45° FOV:
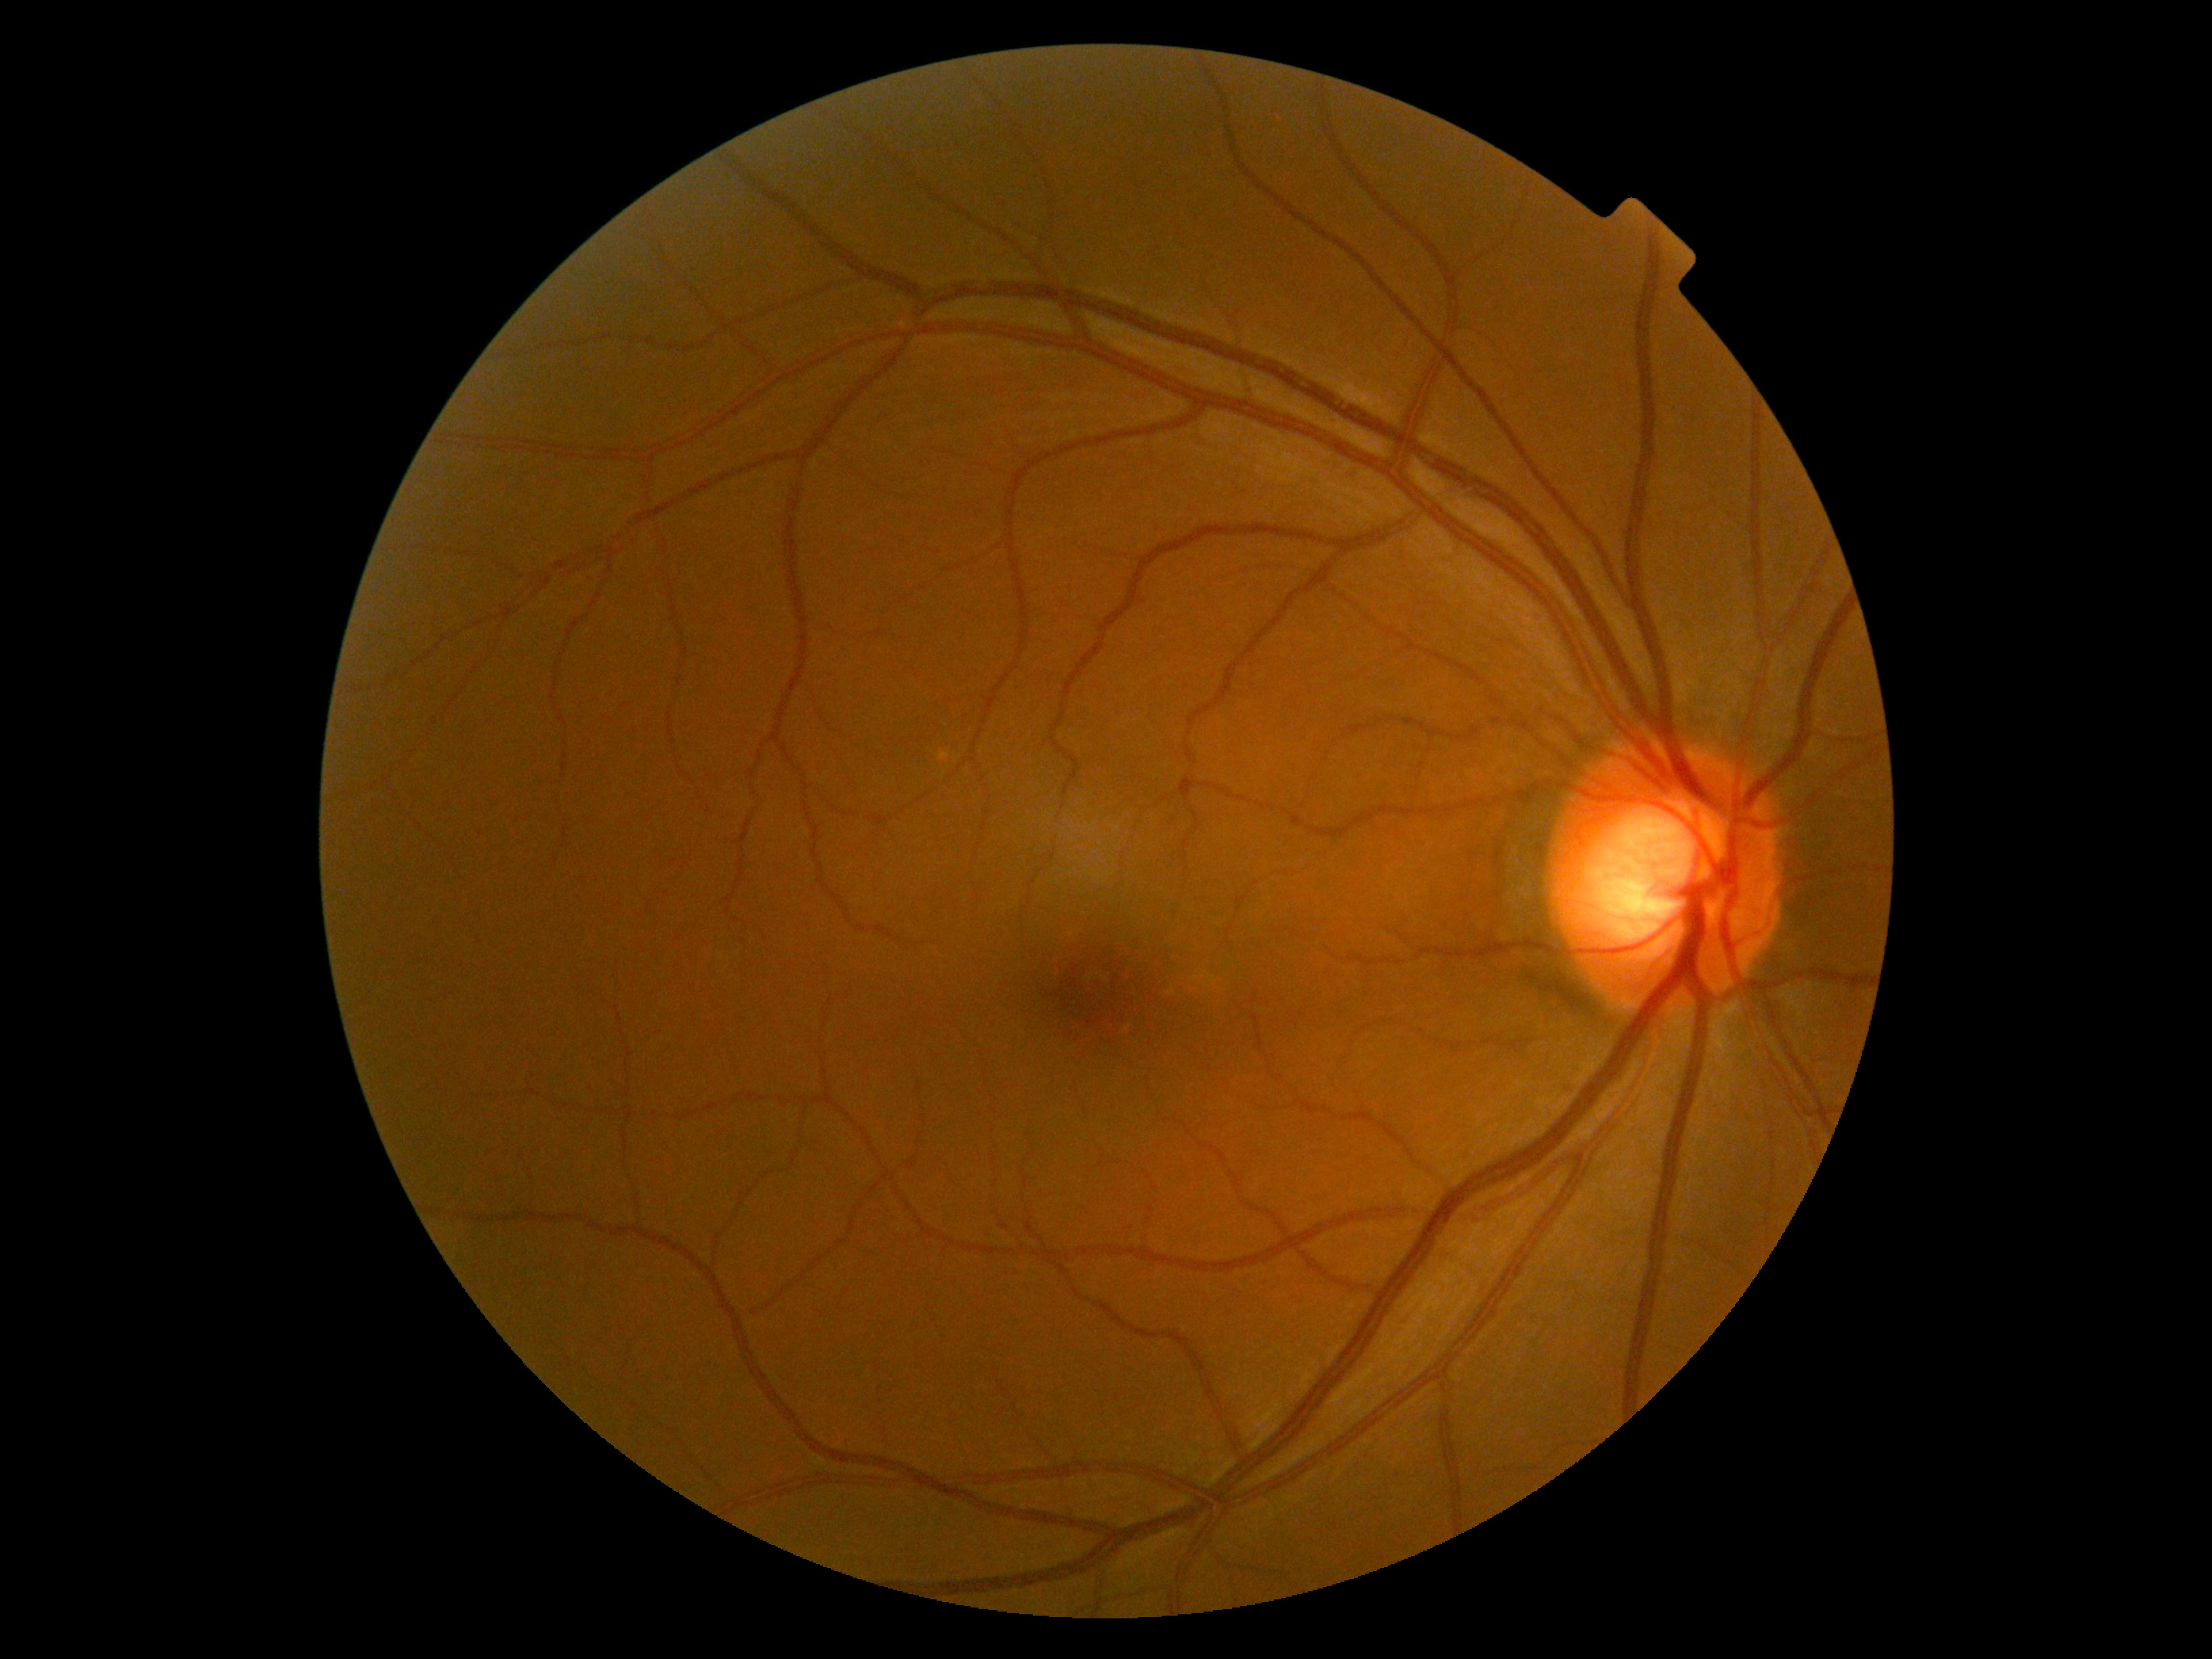

dr_grade: 0